Captured with the Natus RetCam Envision (130° field of view). RetCam wide-field infant fundus image:
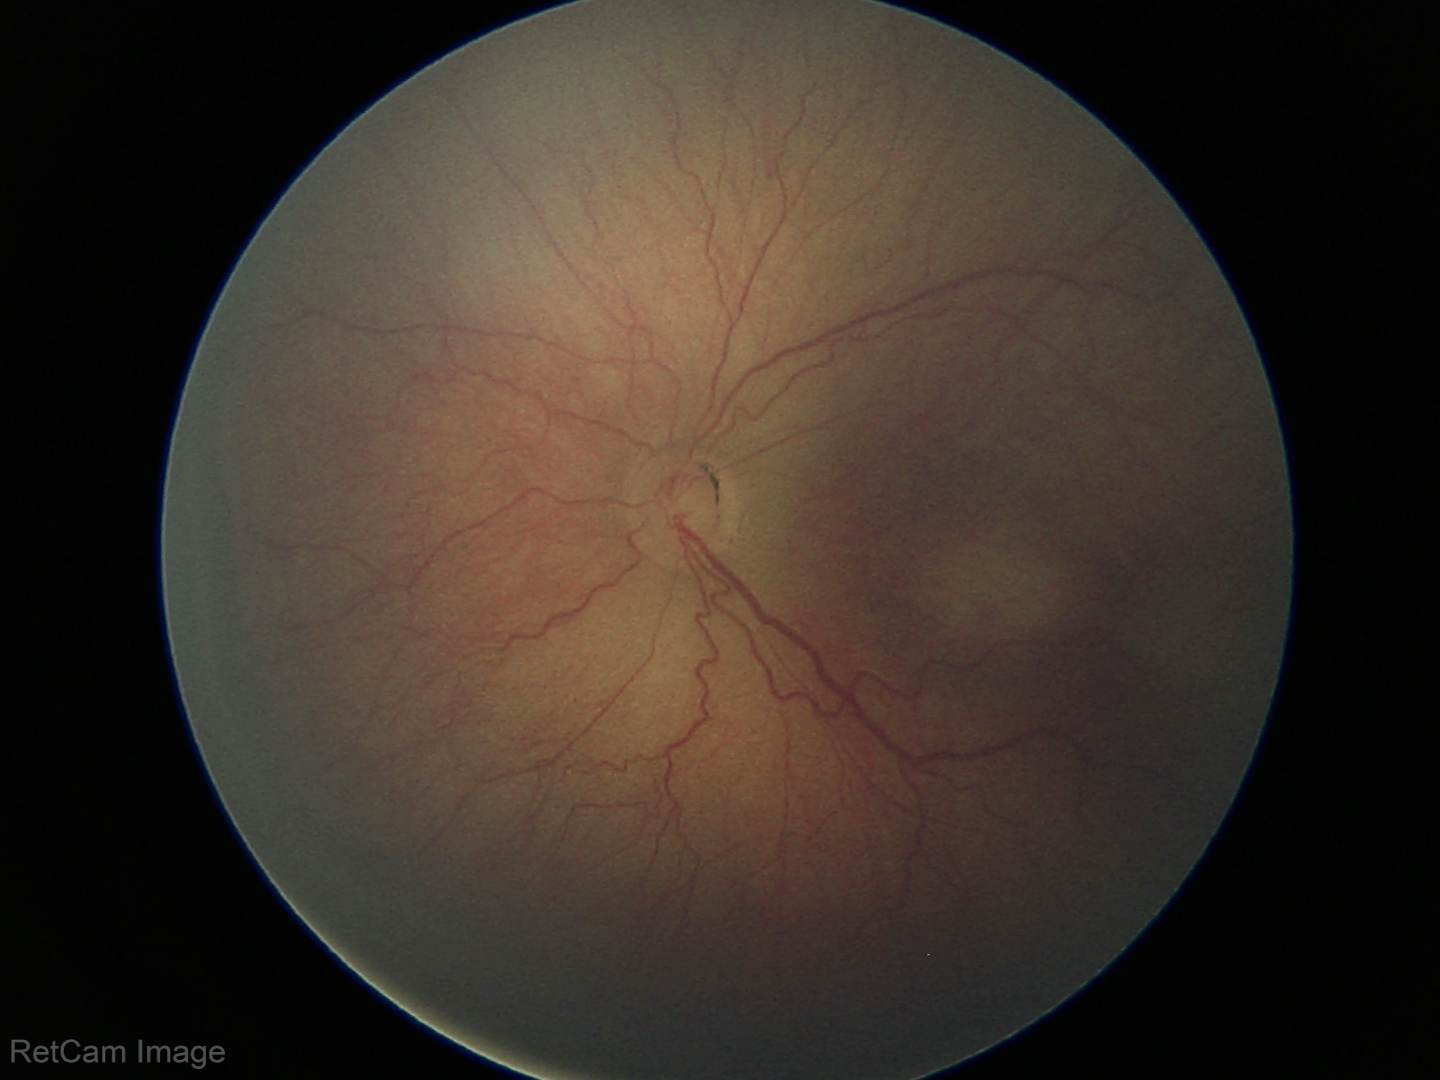

Assessment: ROP stage 3.